Infant wide-field retinal image
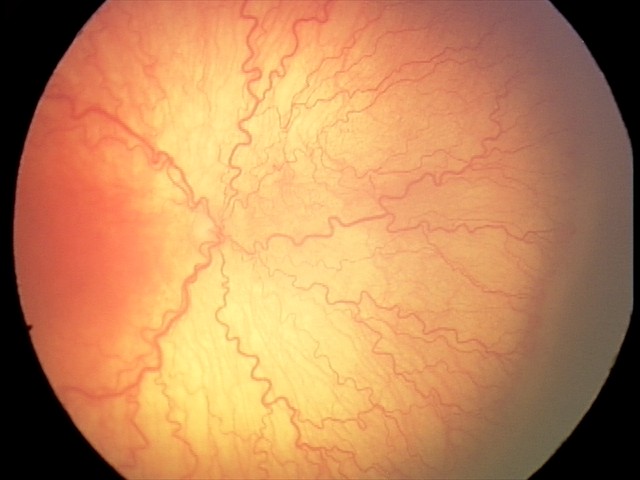 From an examination with diagnosis of A-ROP (aggressive ROP). Plus disease present.